1932 x 1910 pixels · retinal fundus photograph:
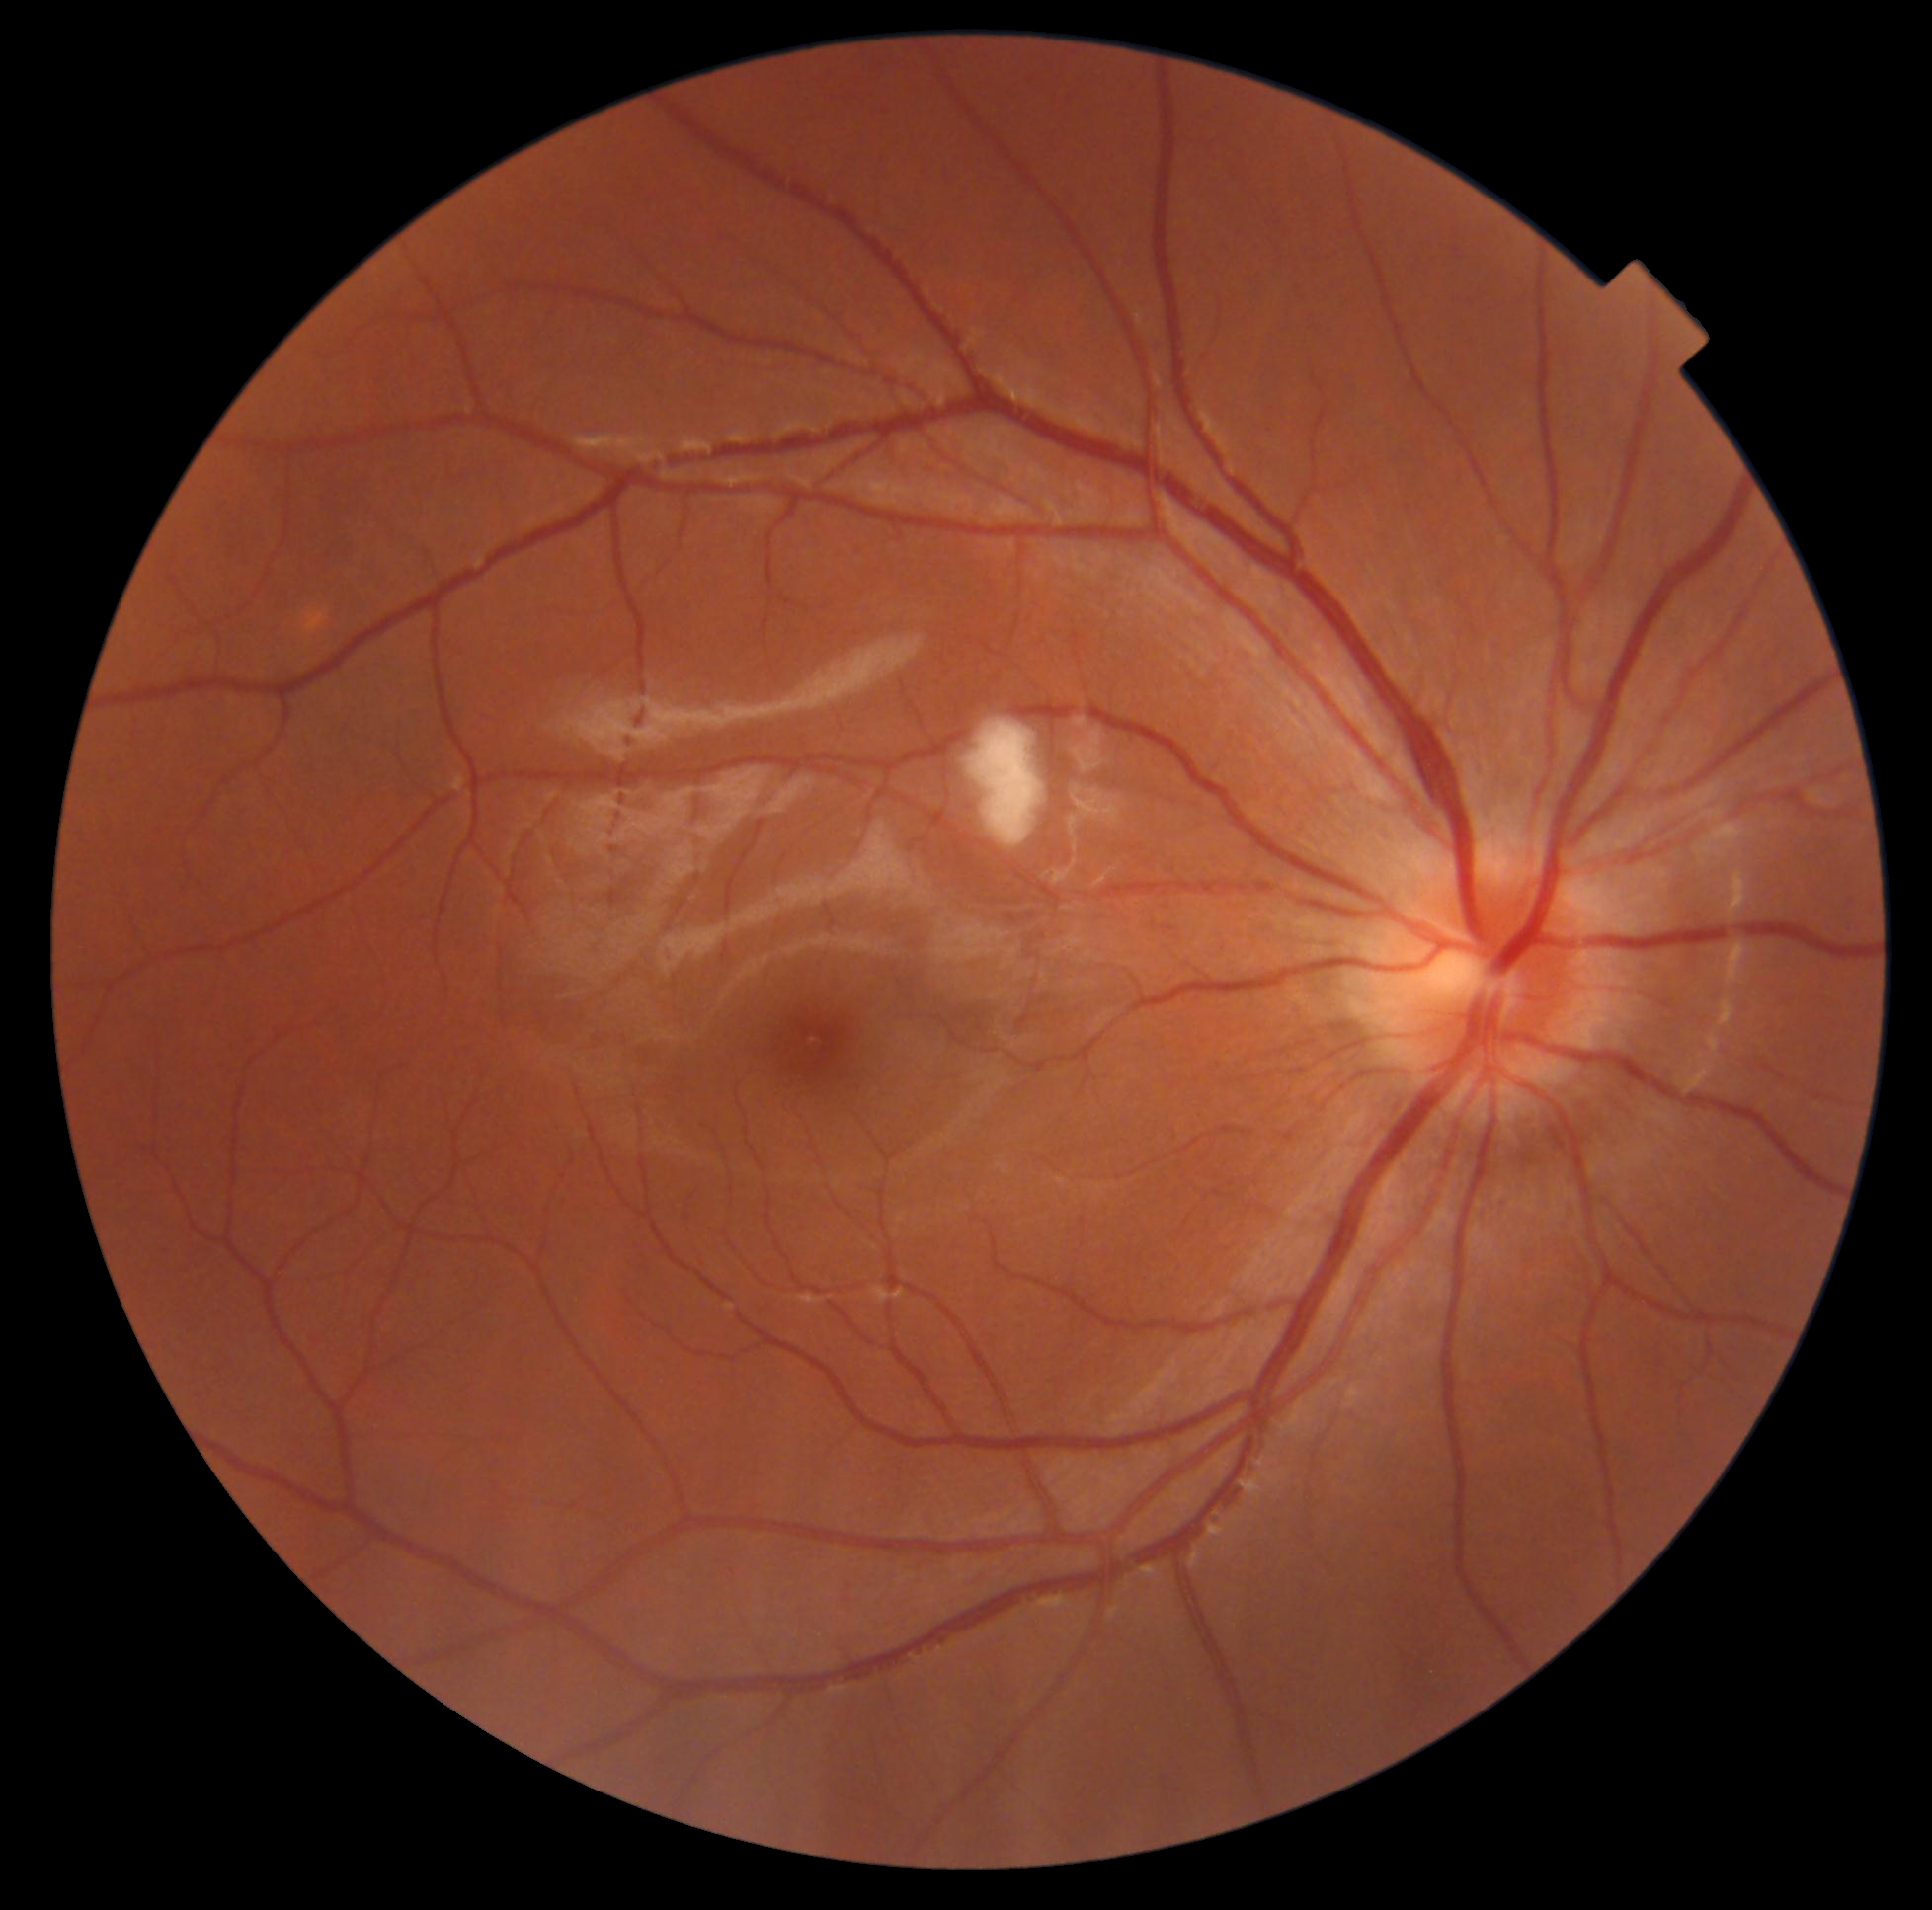 DR class: non-proliferative diabetic retinopathy.
DR stage is grade 2 (moderate NPDR).